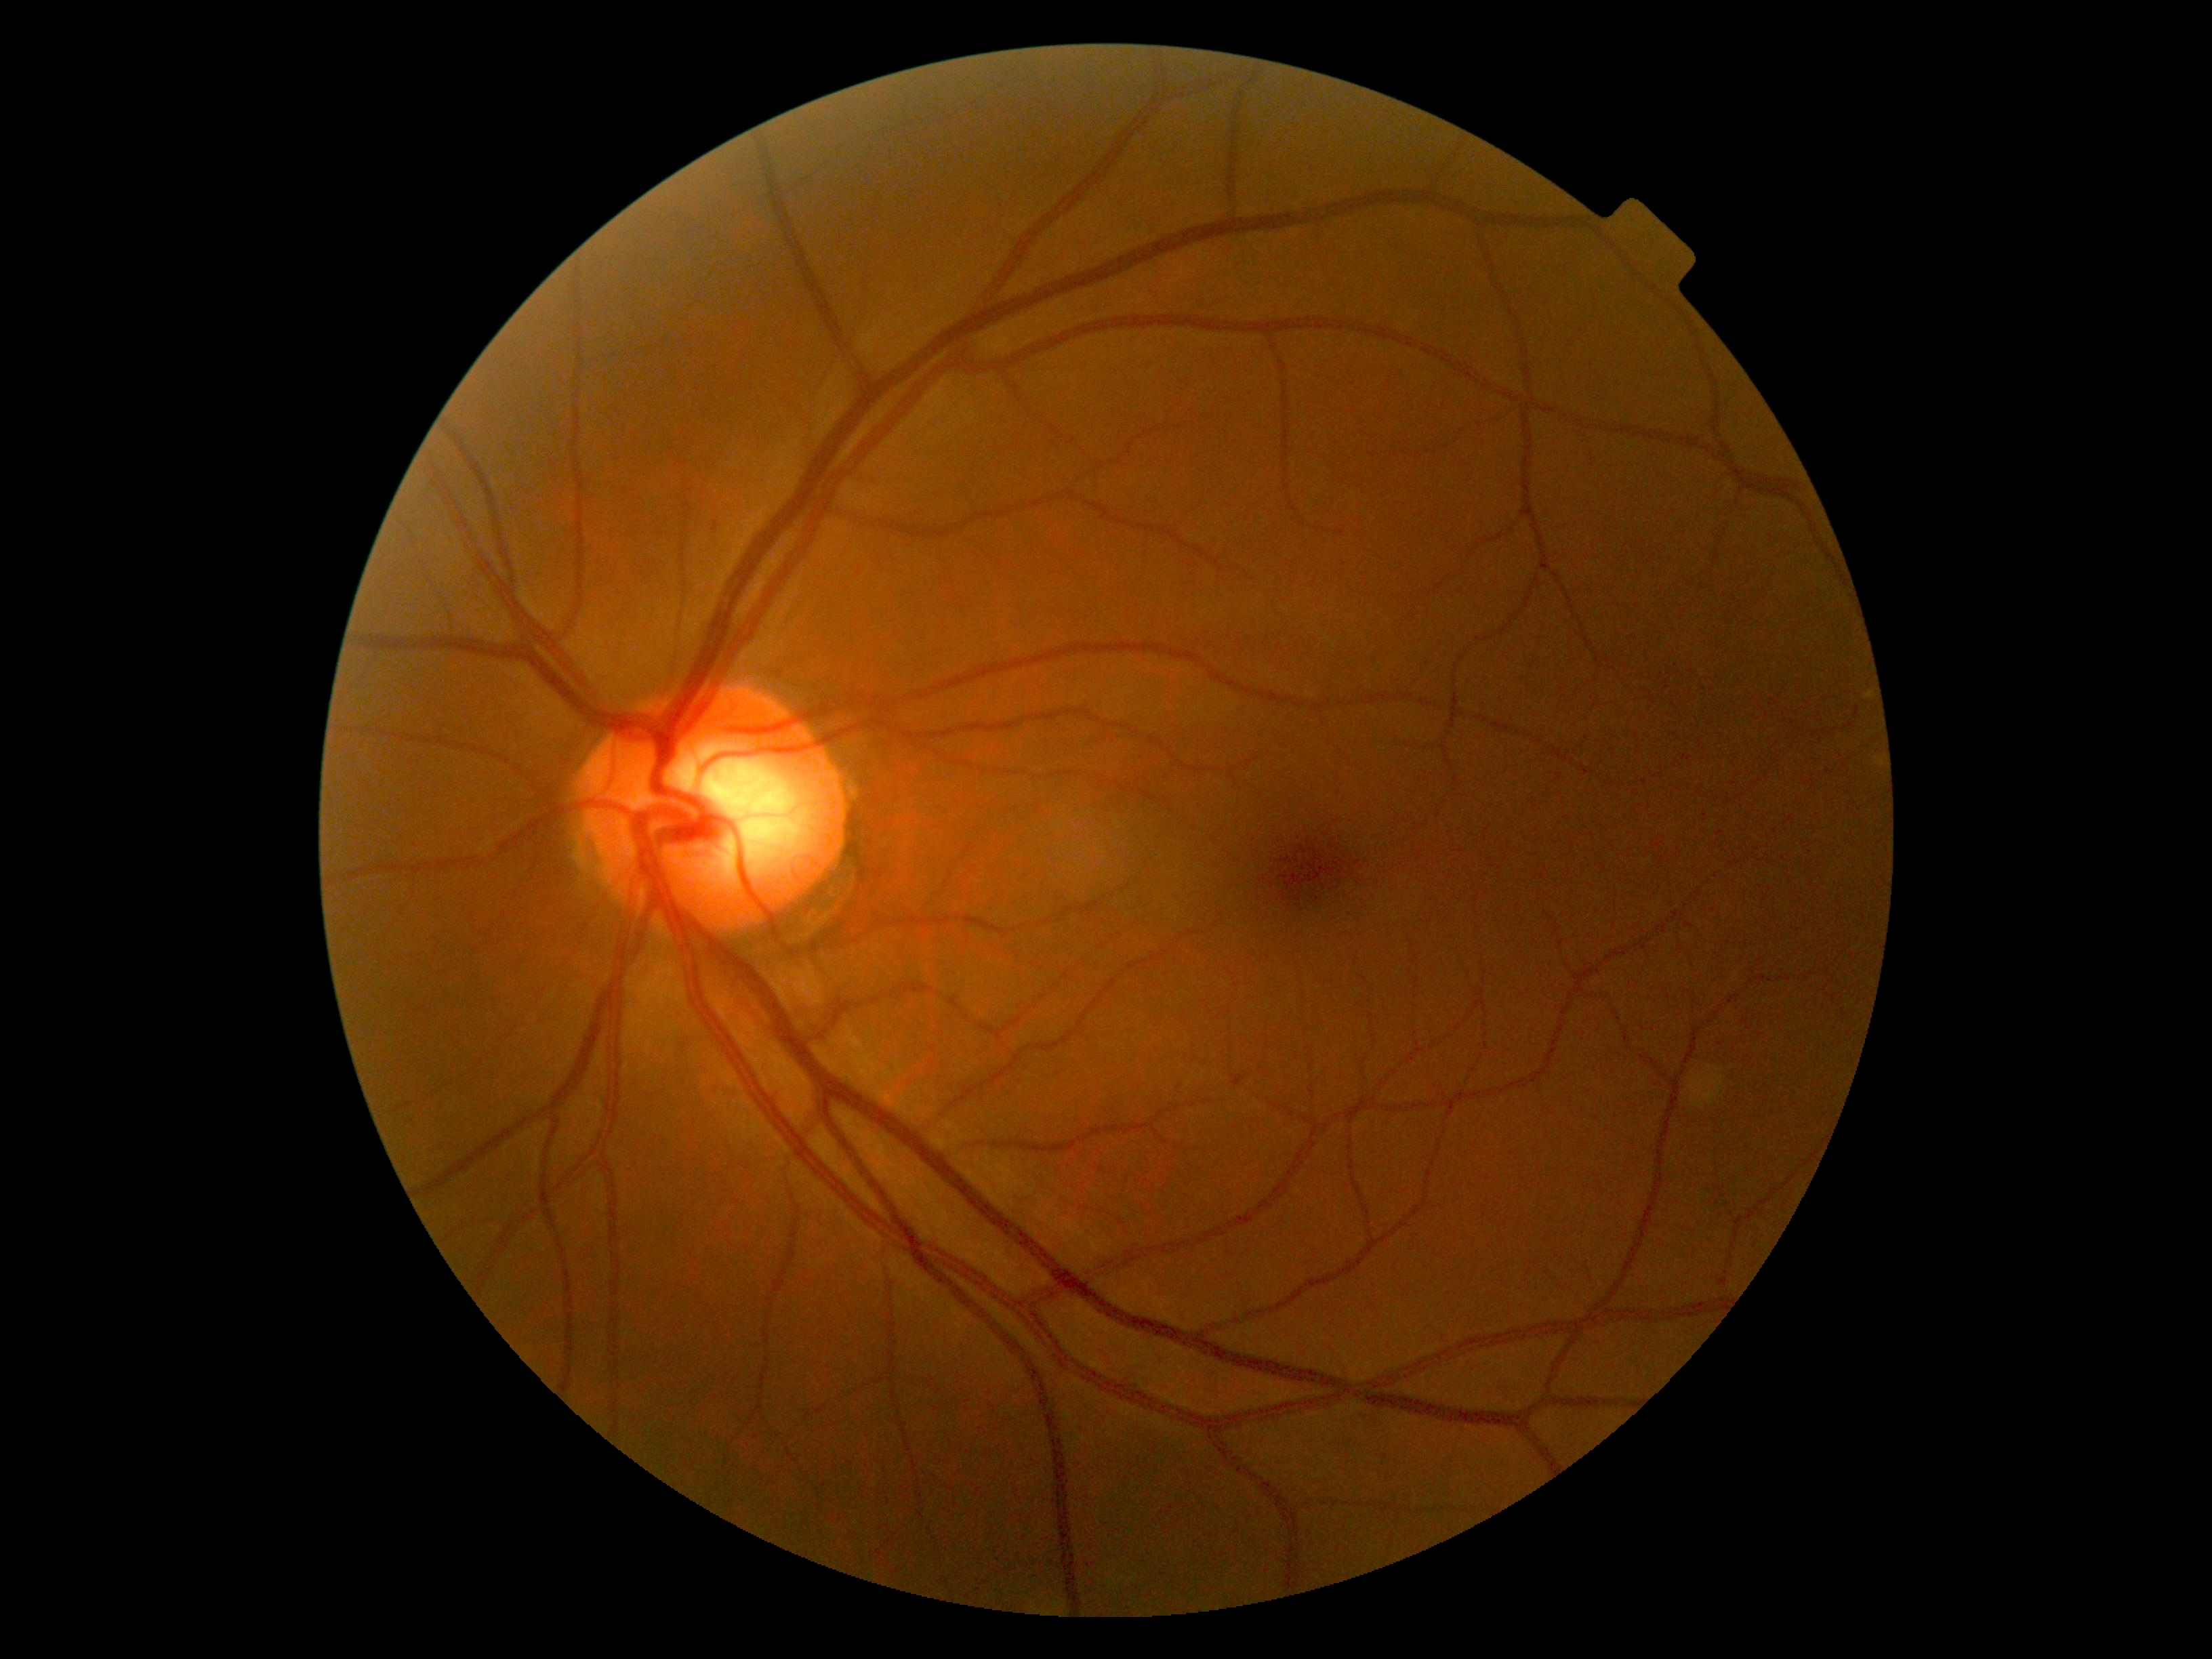

DR impression@no apparent DR; DR@no apparent diabetic retinopathy (grade 0).